Clarity RetCam 3, 130° FOV. Pediatric wide-field fundus photograph. 640x480 — 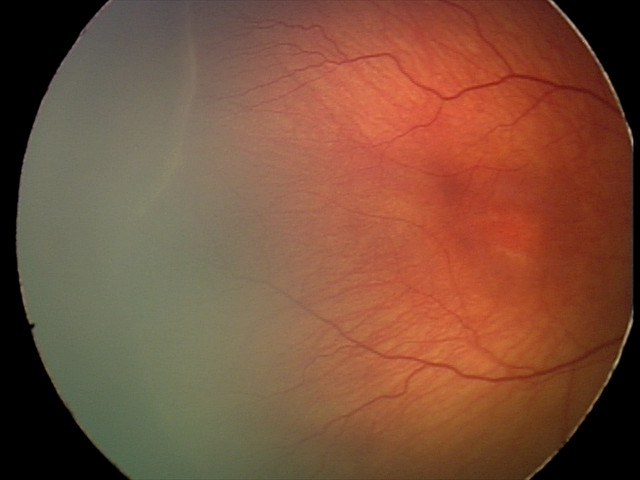

Screening examination consistent with ROP stage 2 — ridge with height and width at the demarcation line. Plus disease absent.